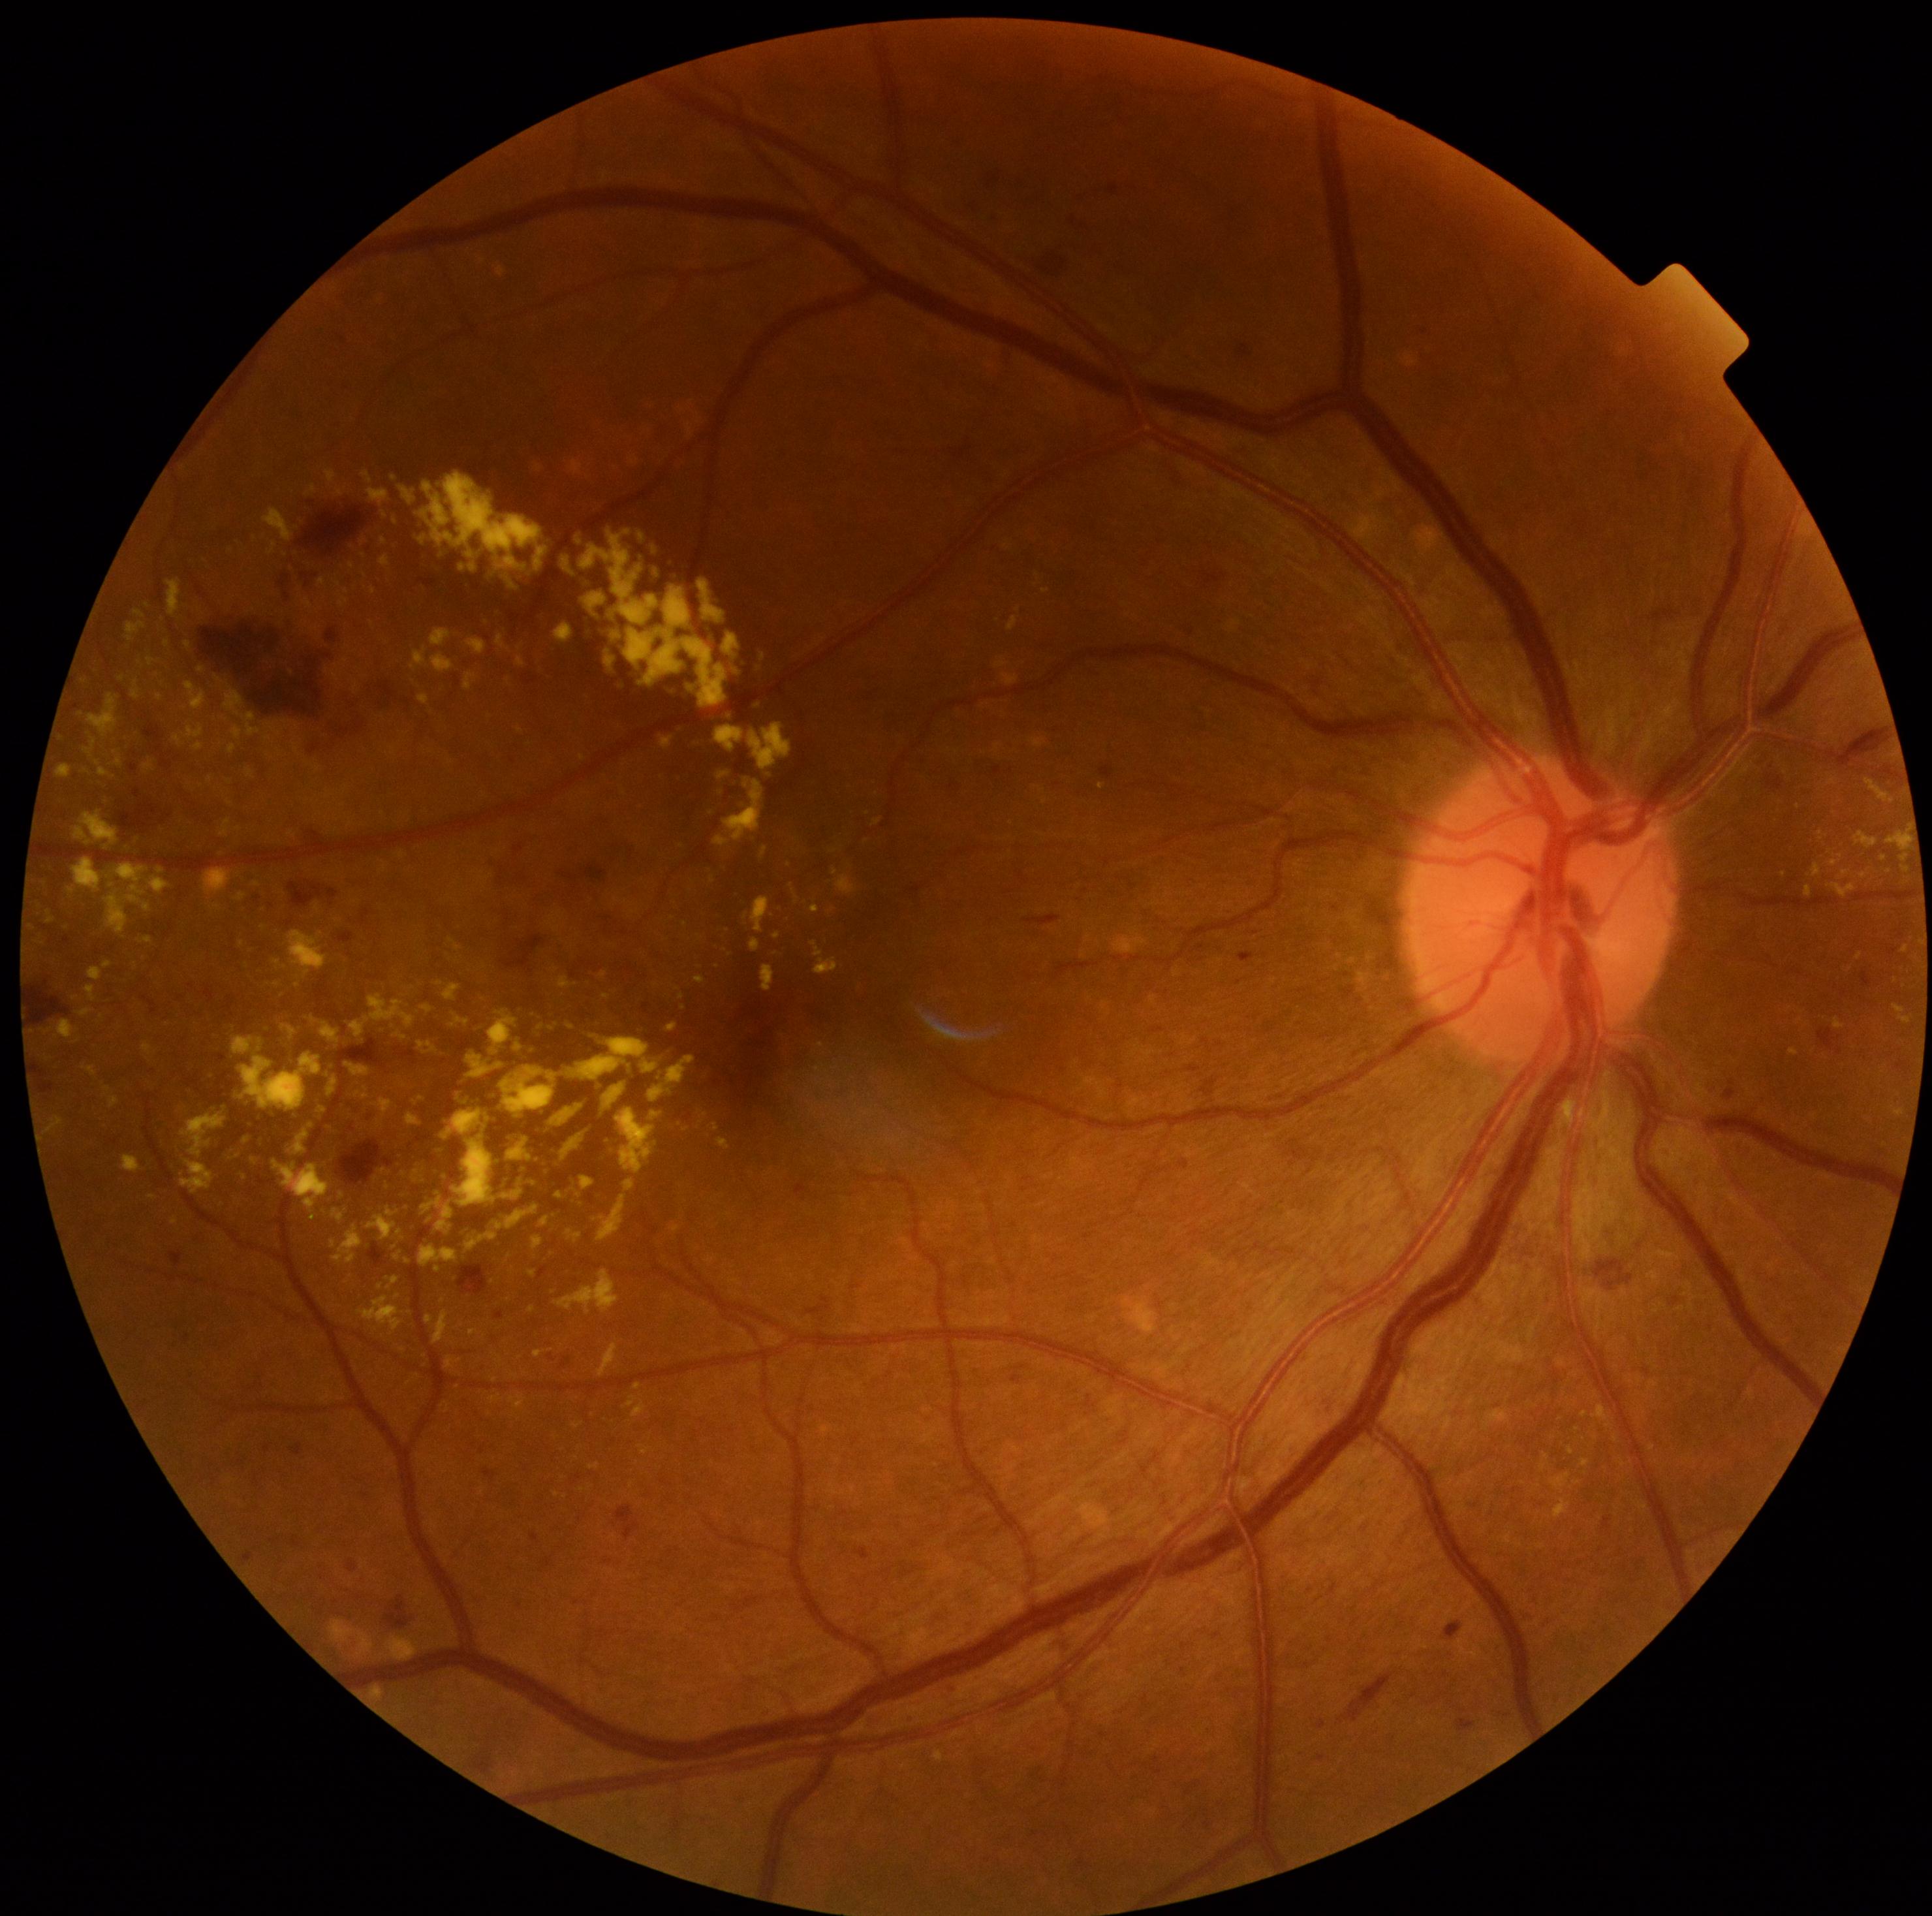

Diabetic retinopathy is grade 2 (moderate NPDR).
Hard exudates (partial list) at (294,743,300,753) | (1839,885,1856,898) | (1903,855,1909,863) | (567,1230,583,1242) | (263,508,293,542) | (126,623,147,642) | (713,778,764,847) | (465,638,486,655) | (615,898,630,906) | (313,765,320,773) | (626,1396,638,1407) | (134,611,146,619) | (147,658,159,665).
Small hard exudates approximately at (327, 1398) | (394, 478) | (681, 997) | (1863, 875) | (320, 609) | (422, 1099) | (384, 1171).